Infant wide-field retinal image
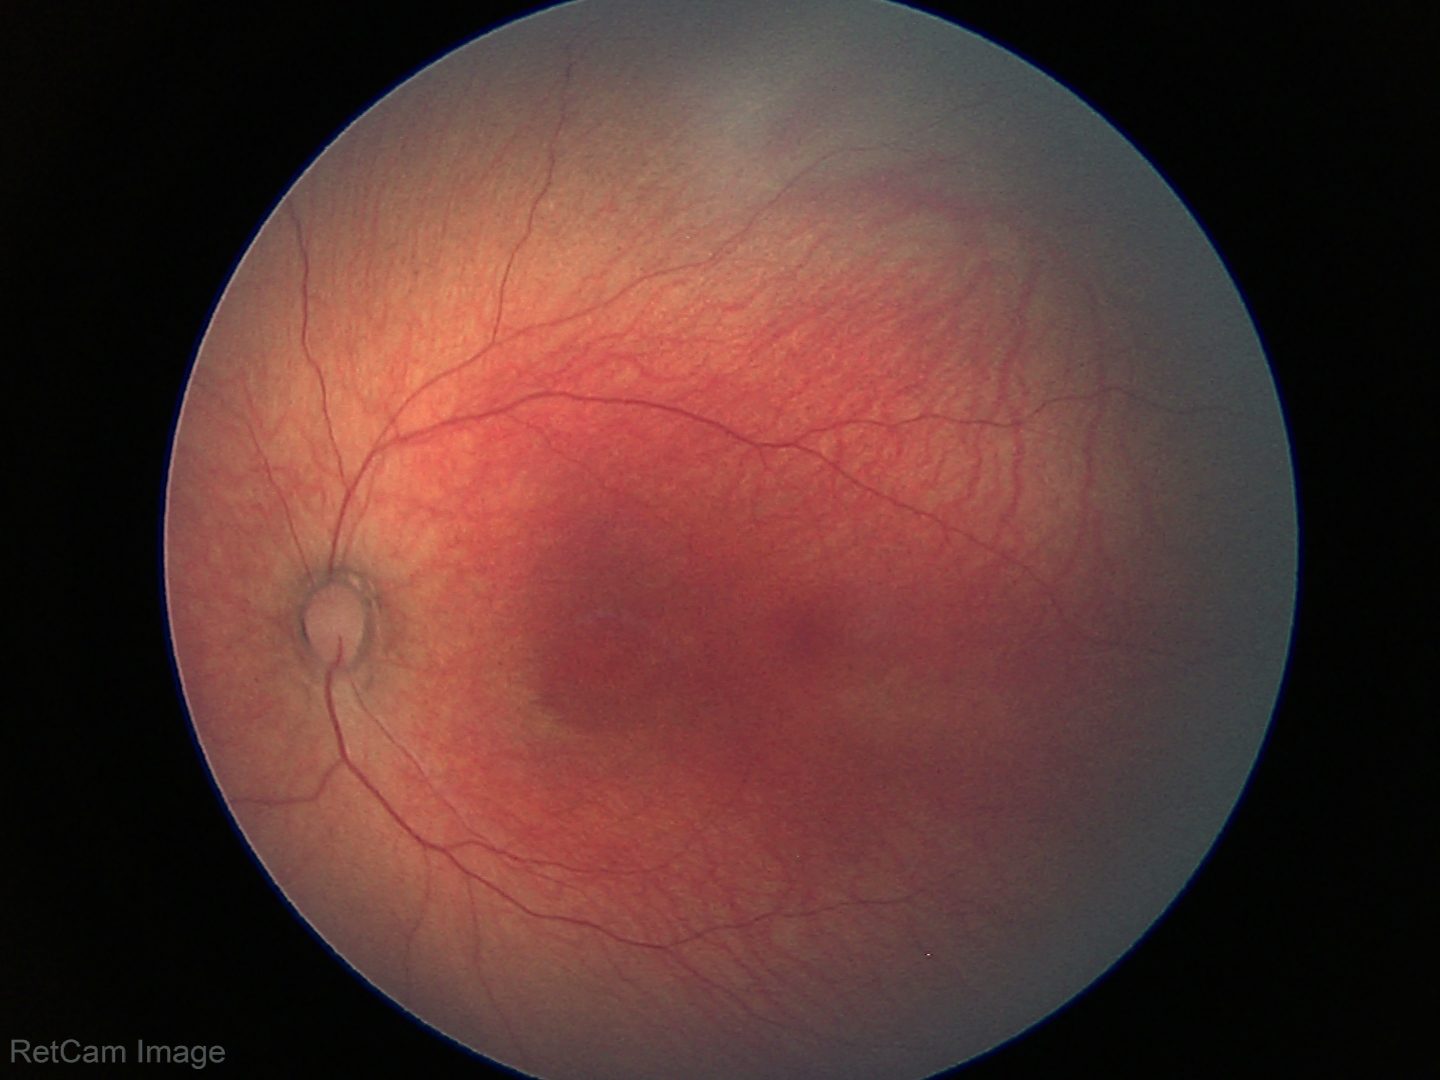
Screening: physiological finding.